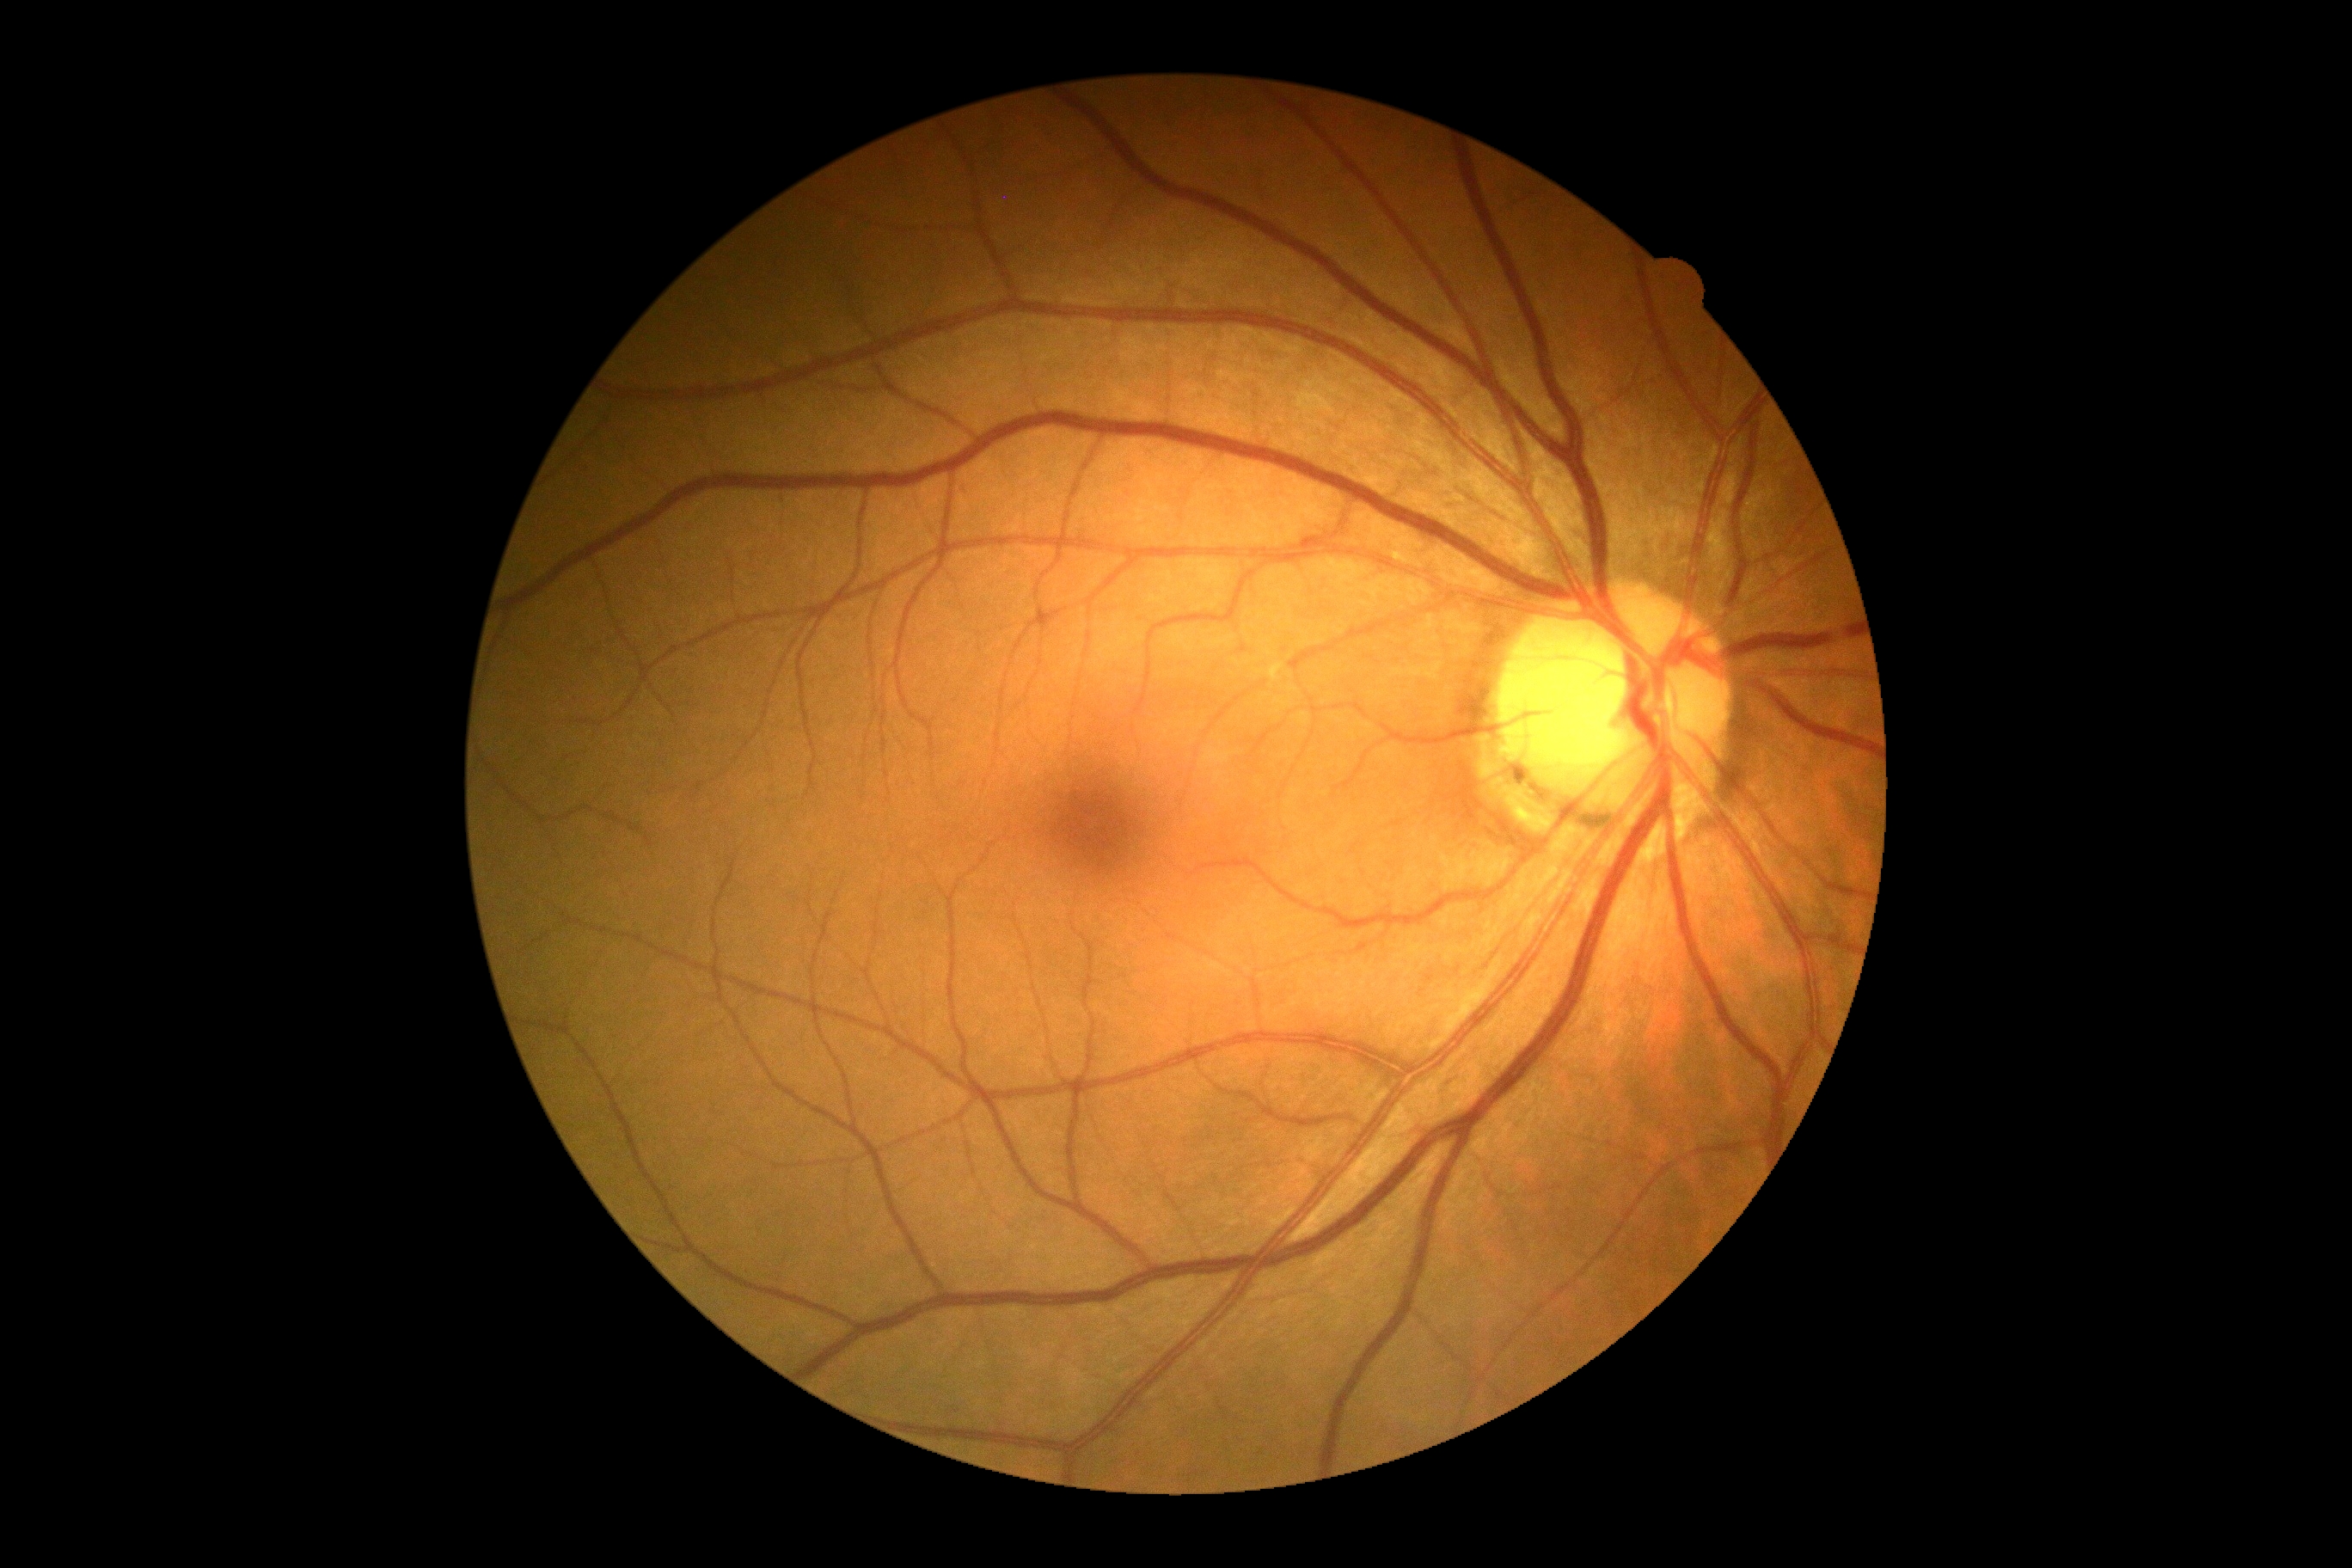

DR impression = no DR findings; diabetic retinopathy (DR) = no apparent retinopathy (grade 0).